Pupil-dilated — 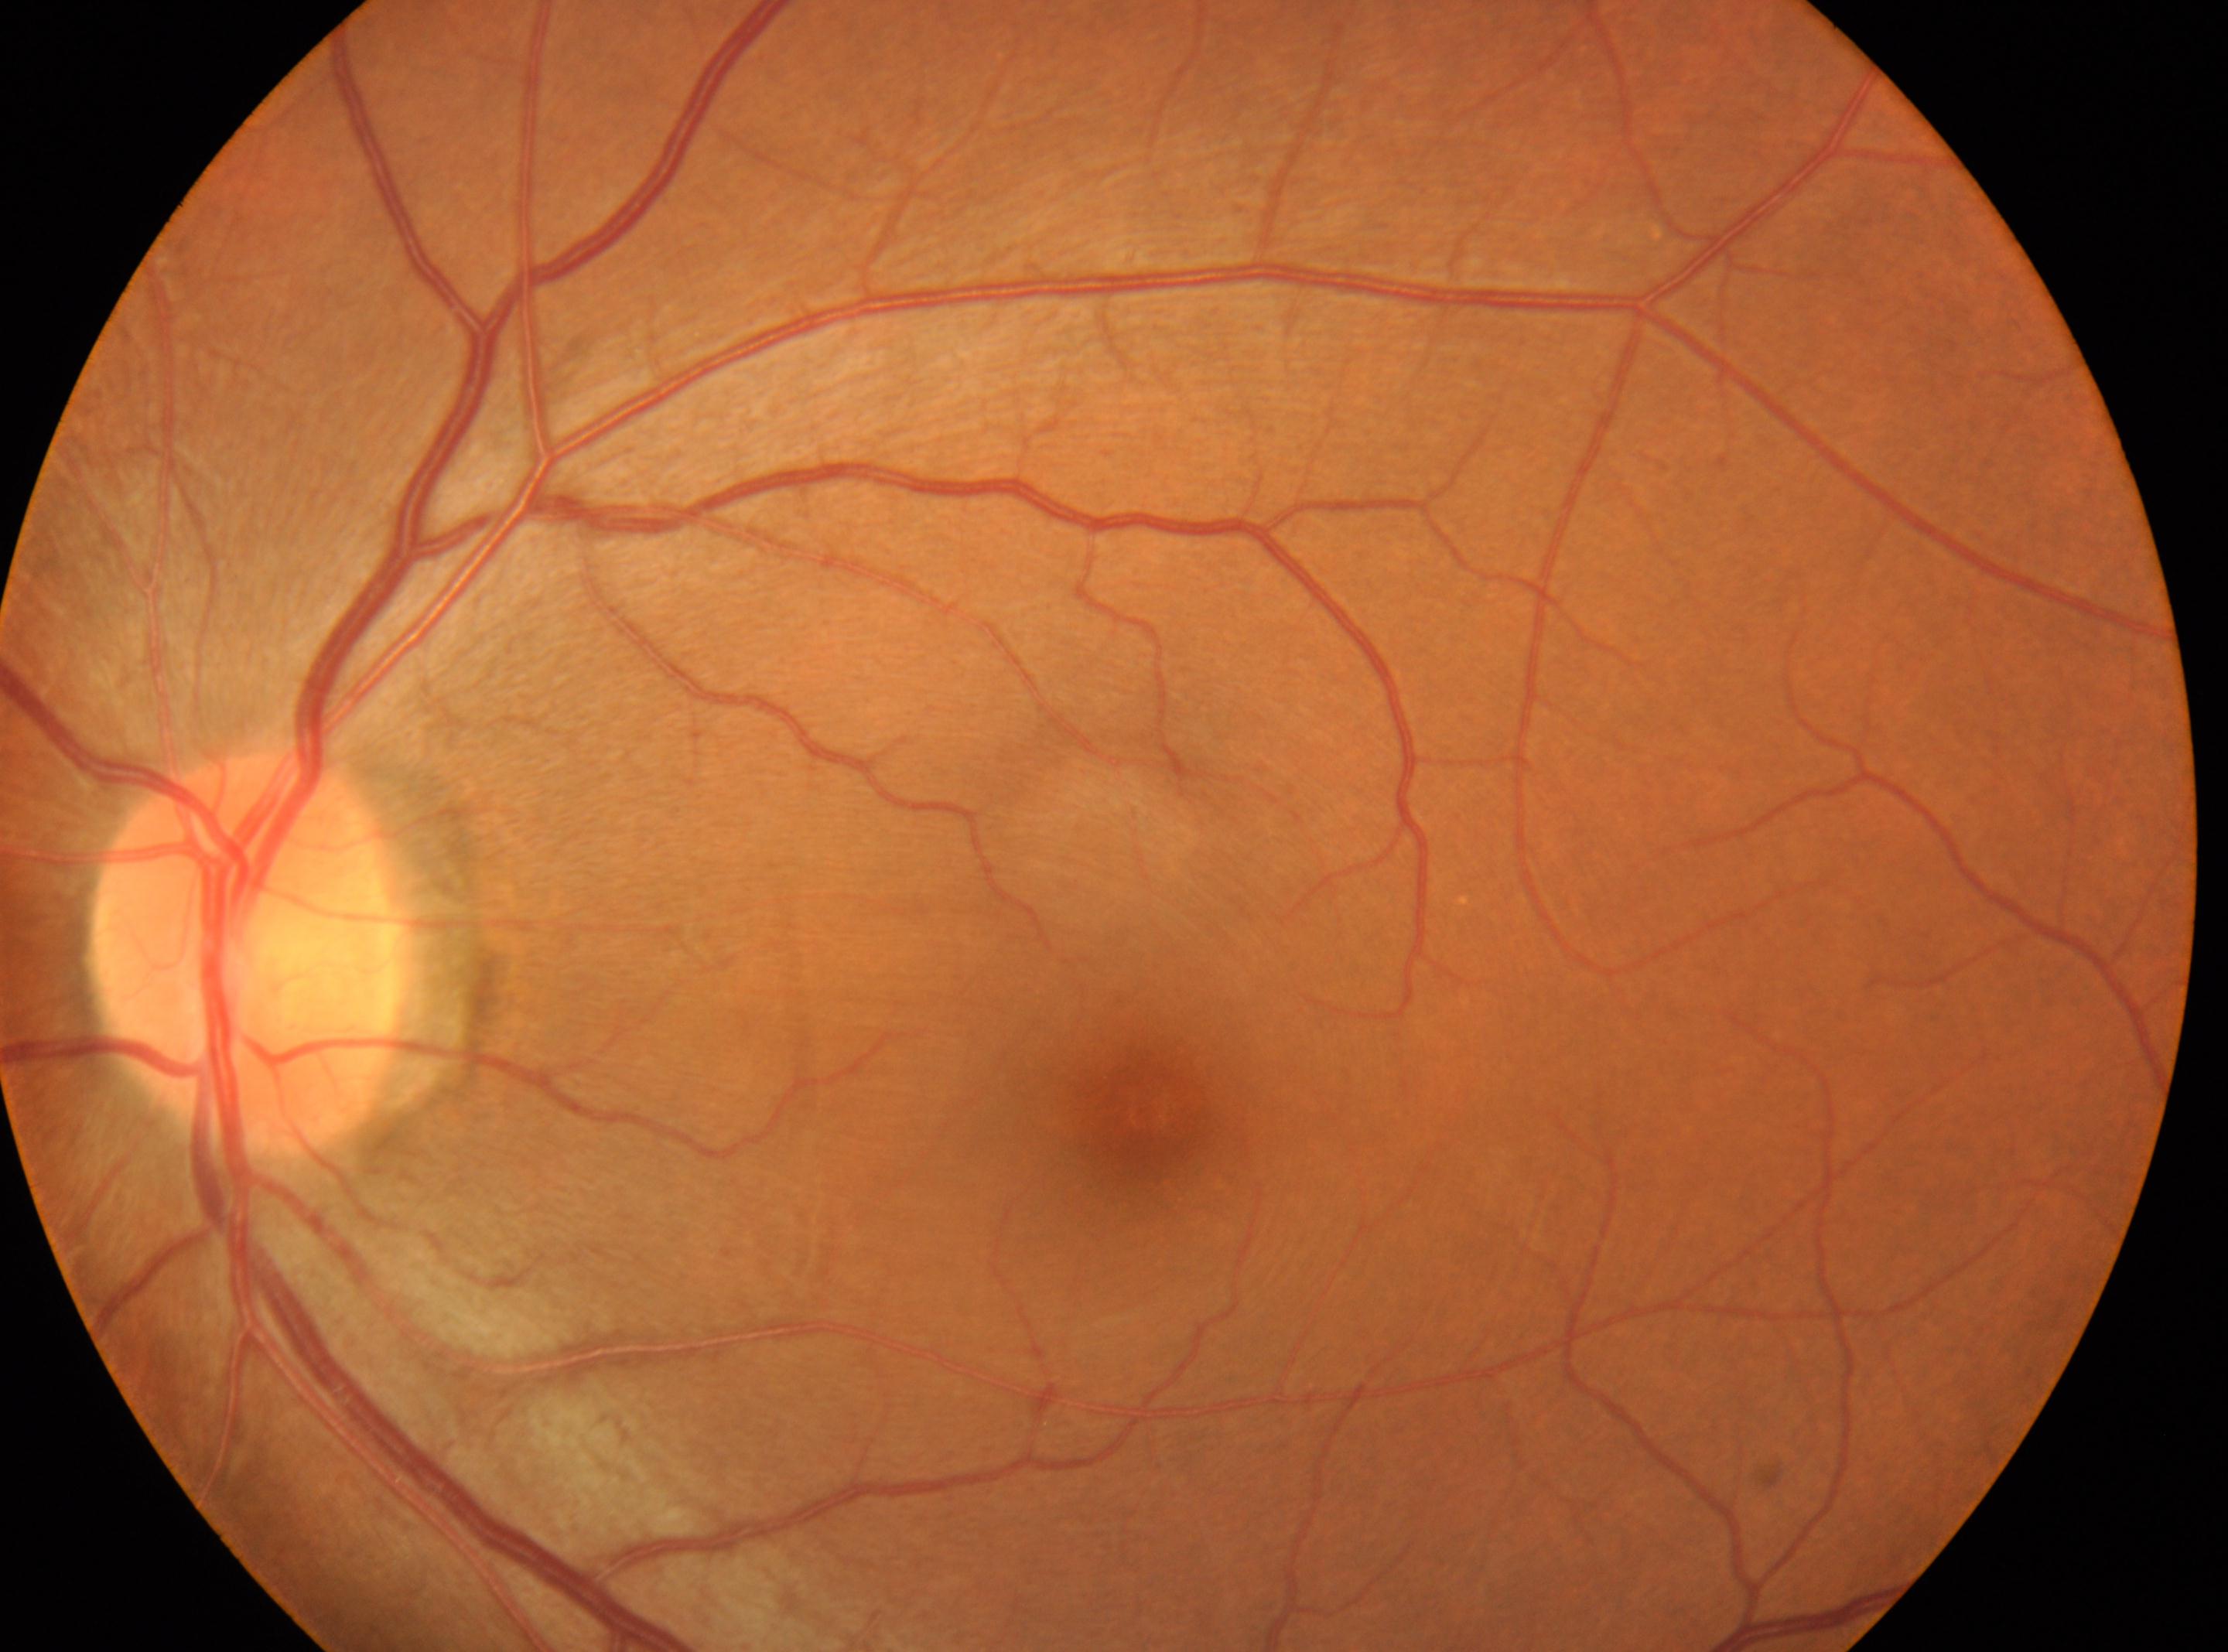 Optic disc: 247, 954.
Fovea center: 1146, 1115.
The image shows the oculus sinister.
Diabetic retinopathy: grade 0 (no apparent retinopathy).
No diabetic retinal disease findings.